45-degree field of view — 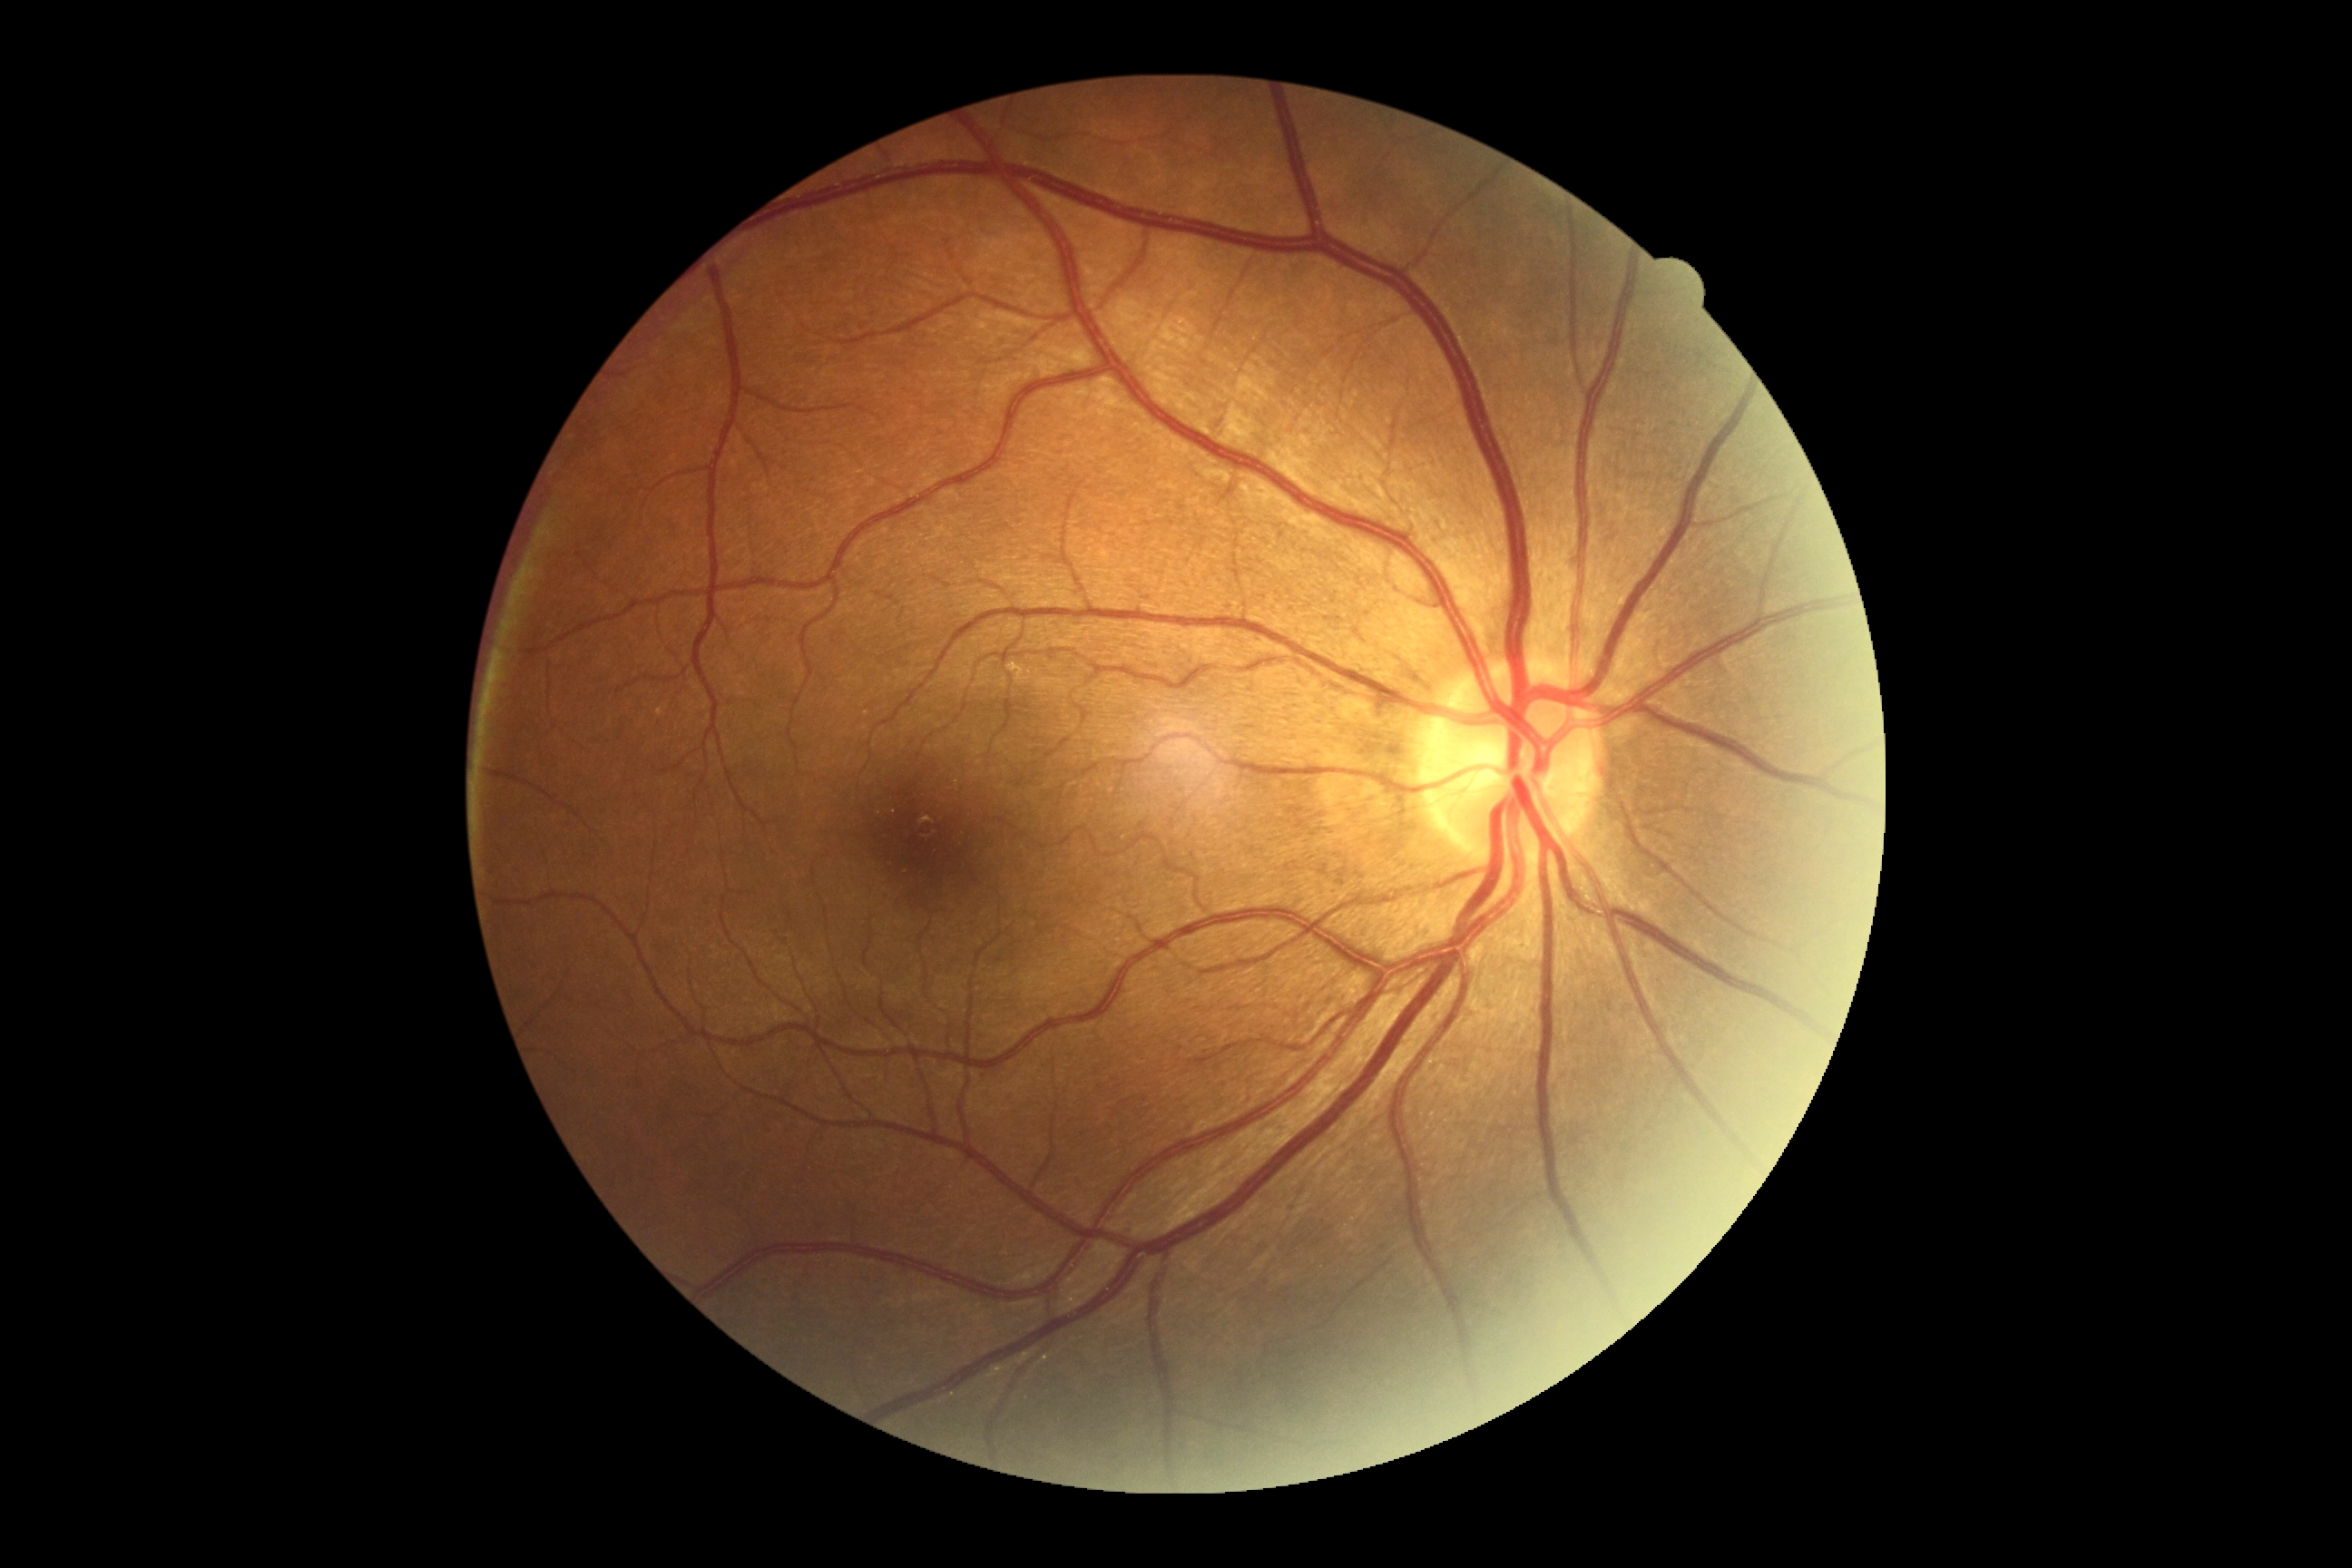 DR grade is 0/4.